Wide-field fundus photograph from neonatal ROP screening: 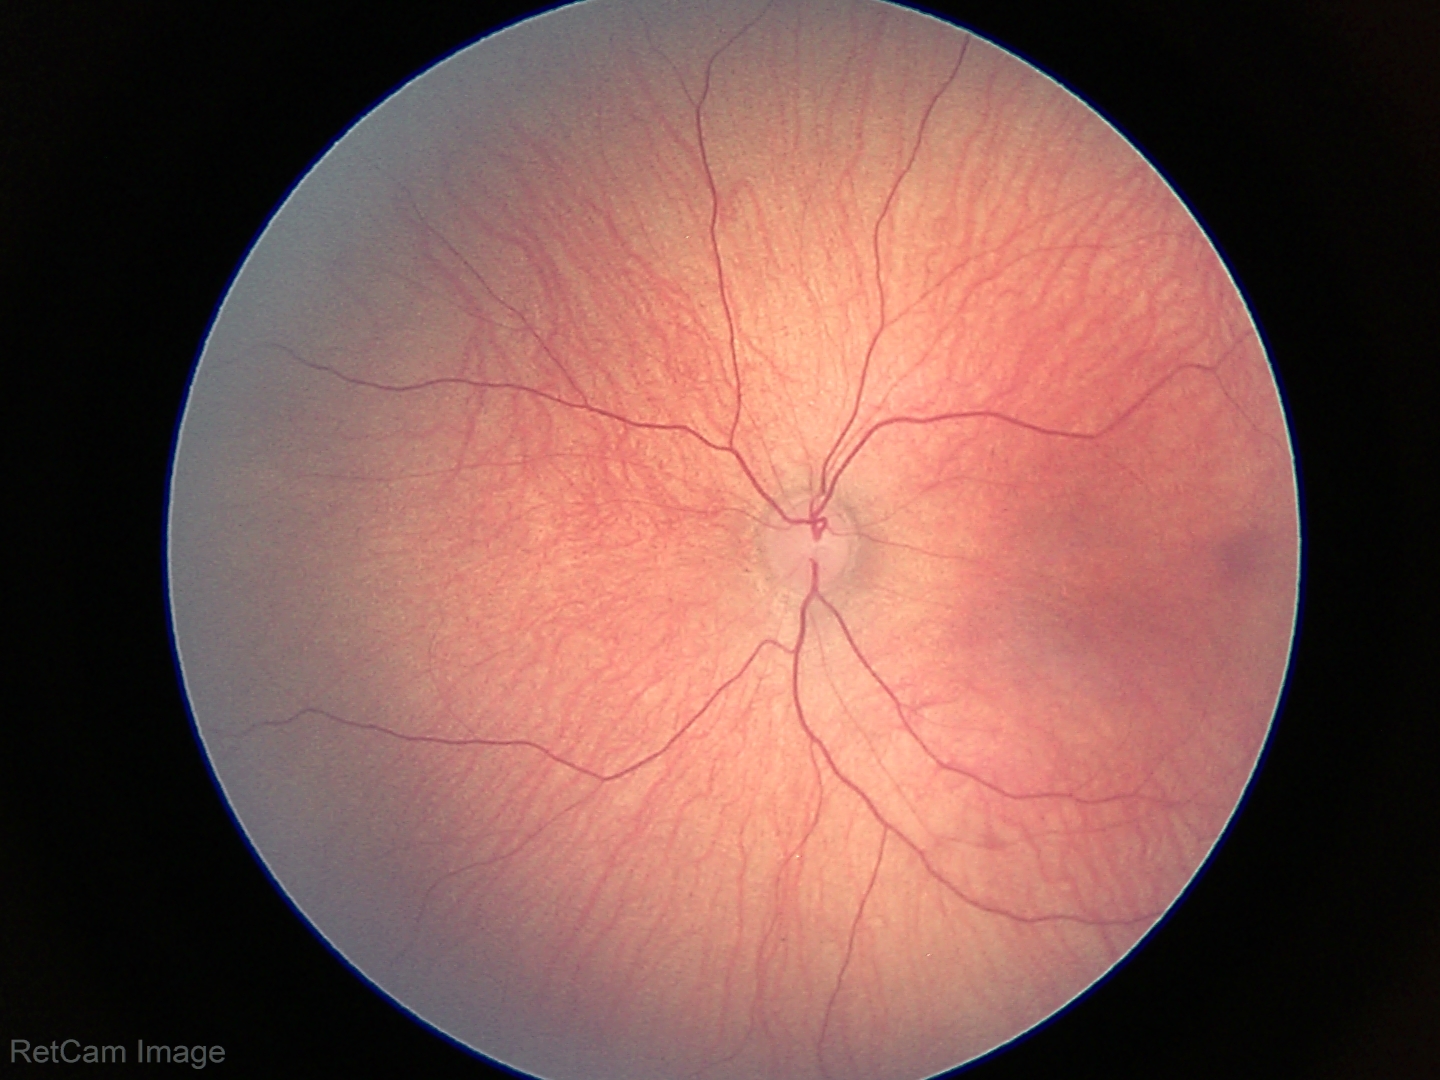
Screening examination with no abnormal retinal findings.